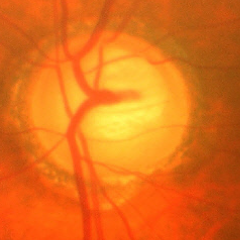
Q: Is glaucoma present?
A: Yes — advanced glaucoma.